Camera: Remidio smartphone fundus camera: 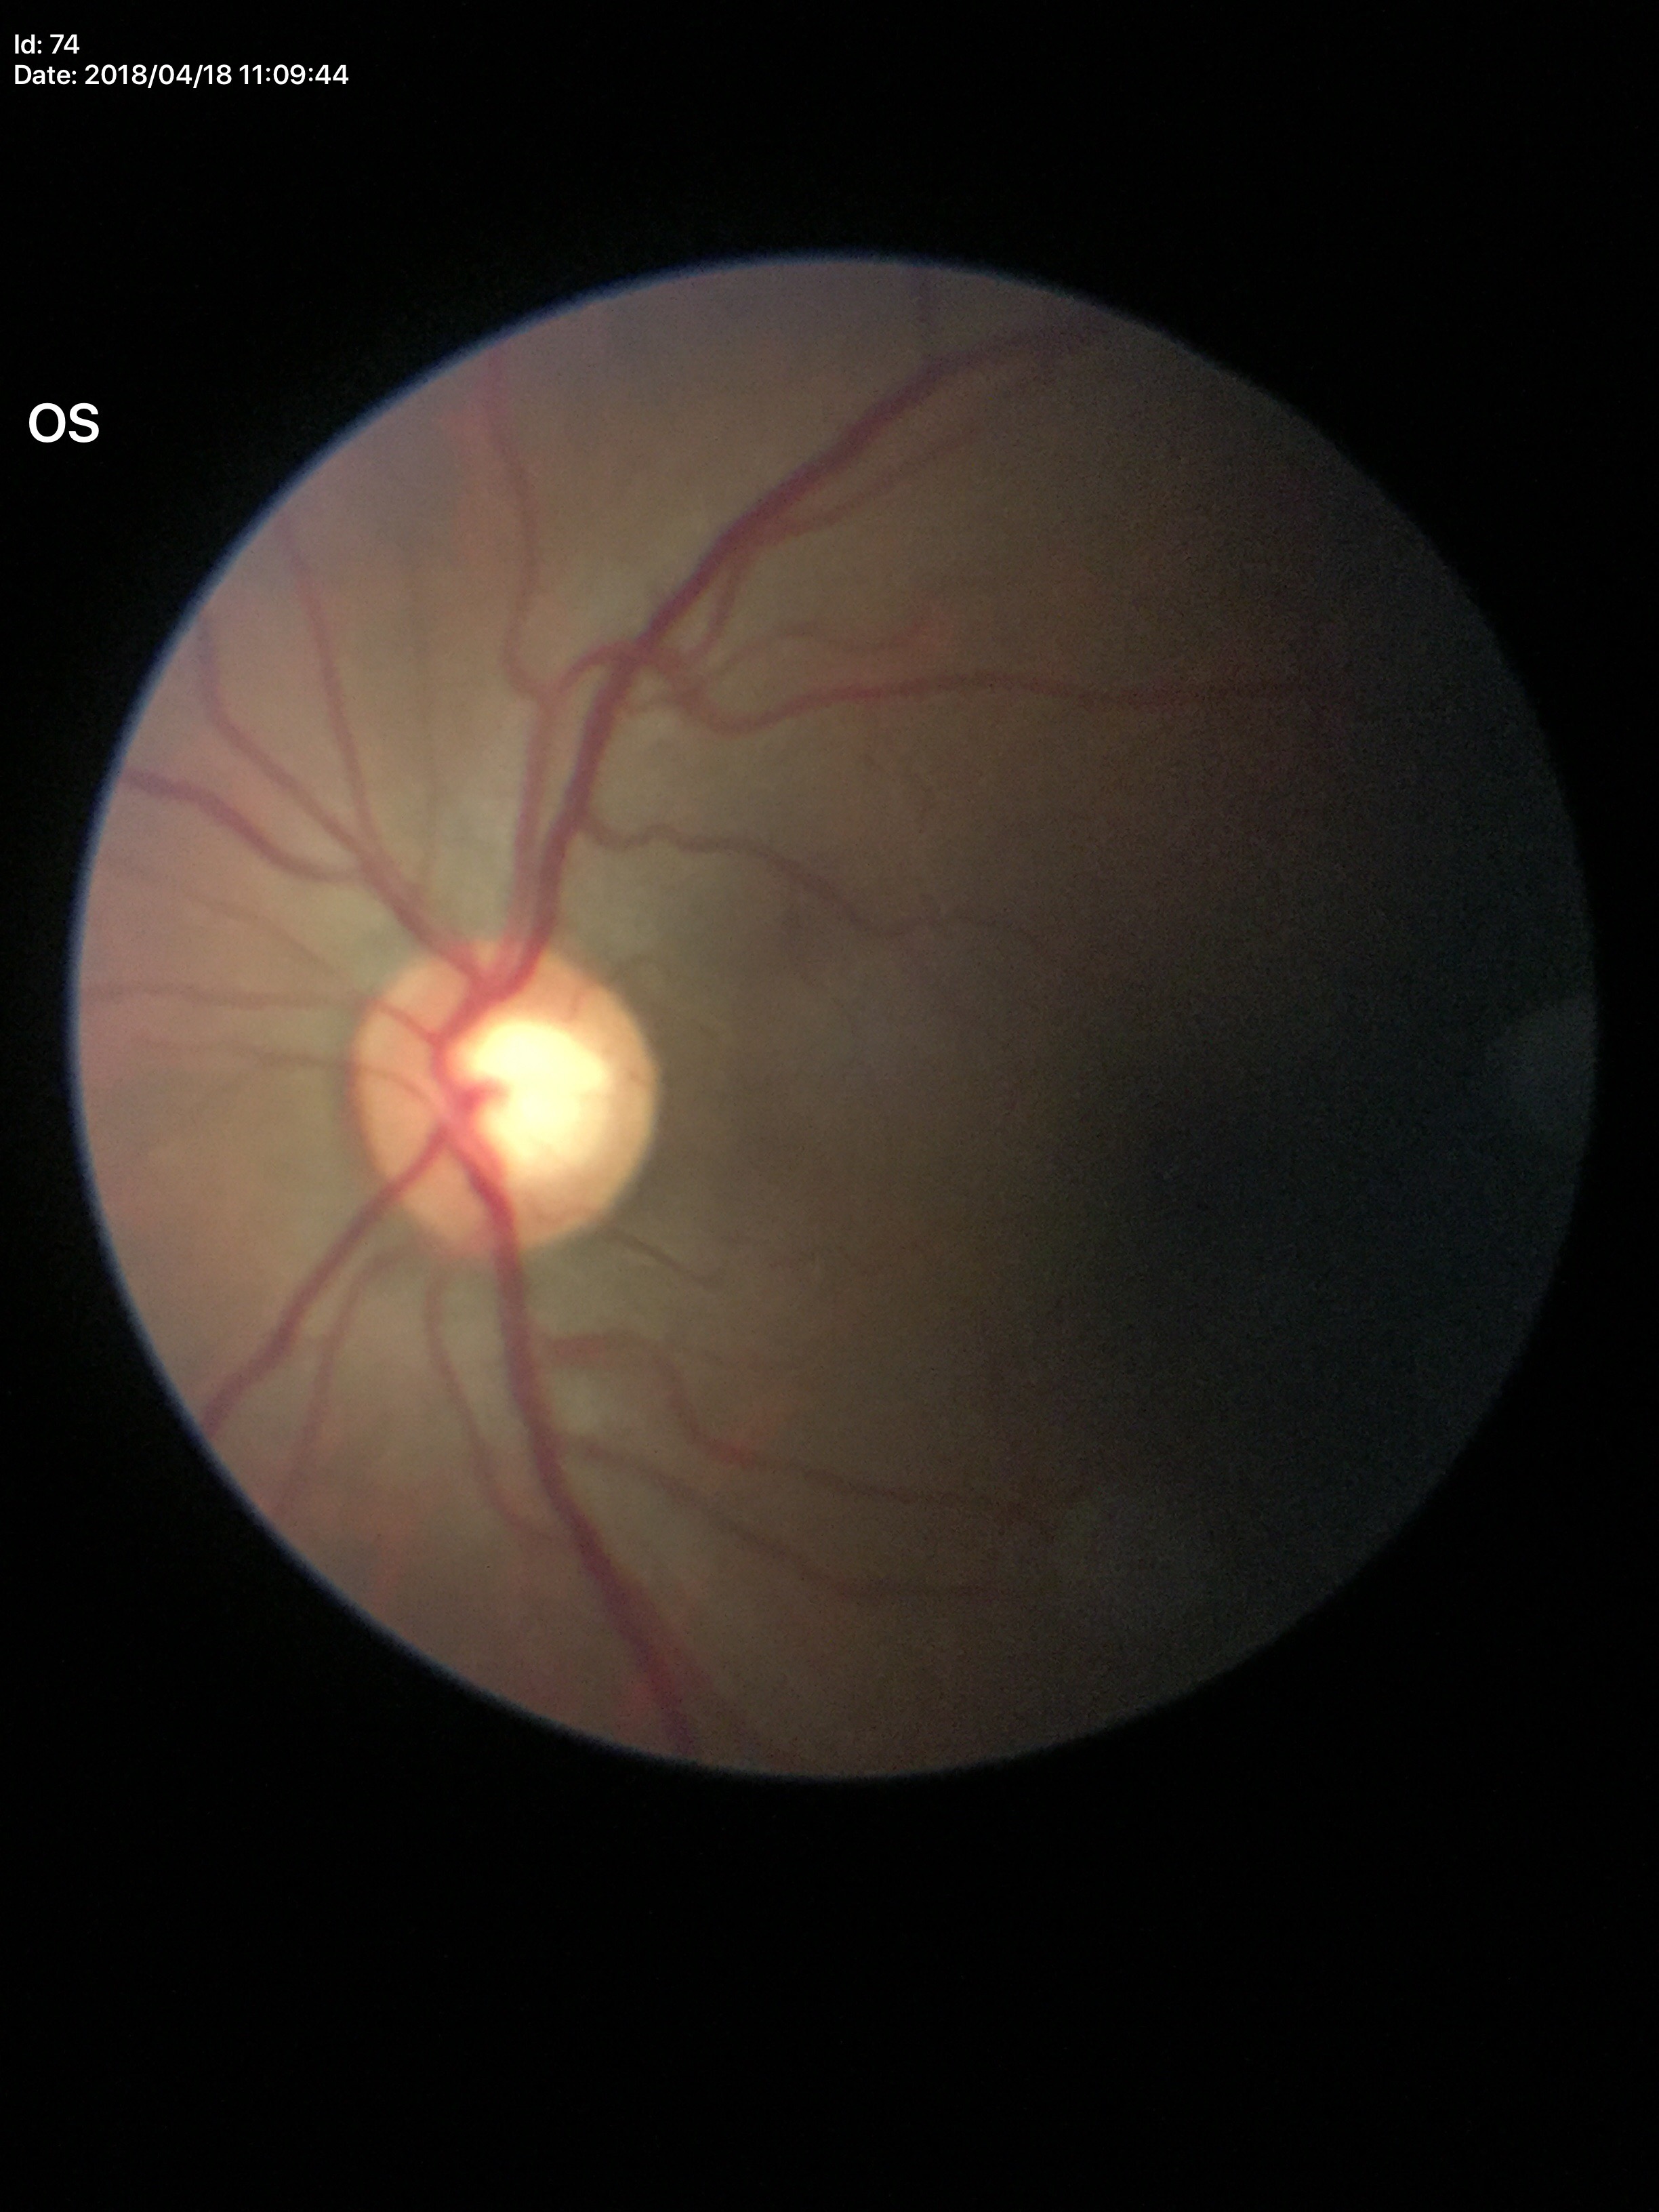

Glaucoma screening=negative
VCDR=0.57